Modified Davis grading — 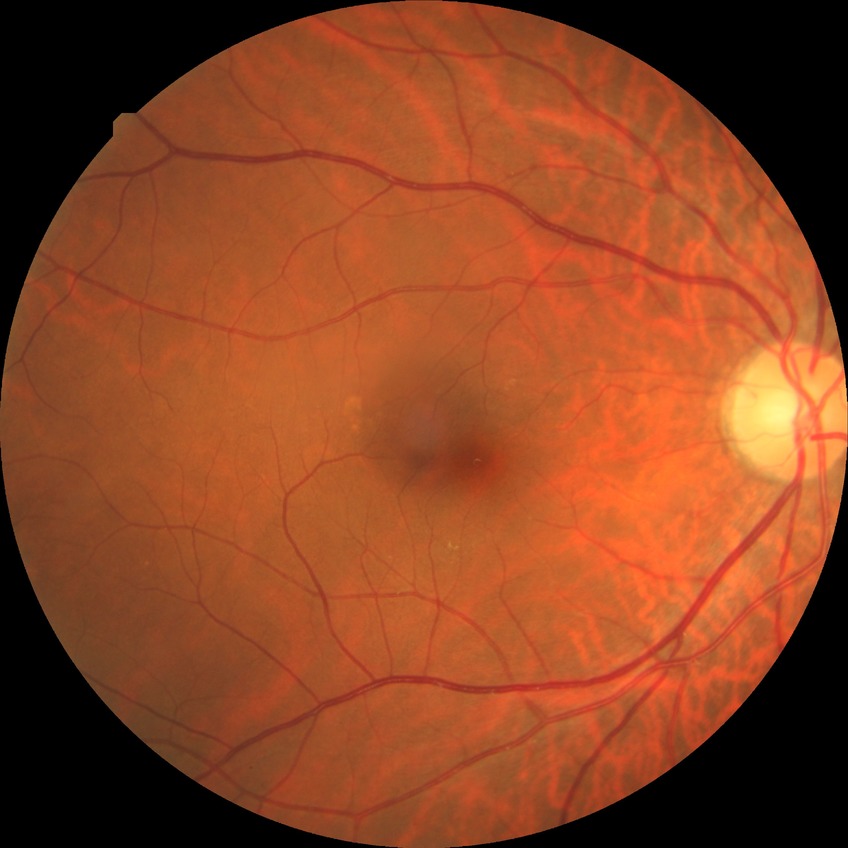 diabetic retinopathy (DR) = no diabetic retinopathy (NDR)